Image size 1932x1916
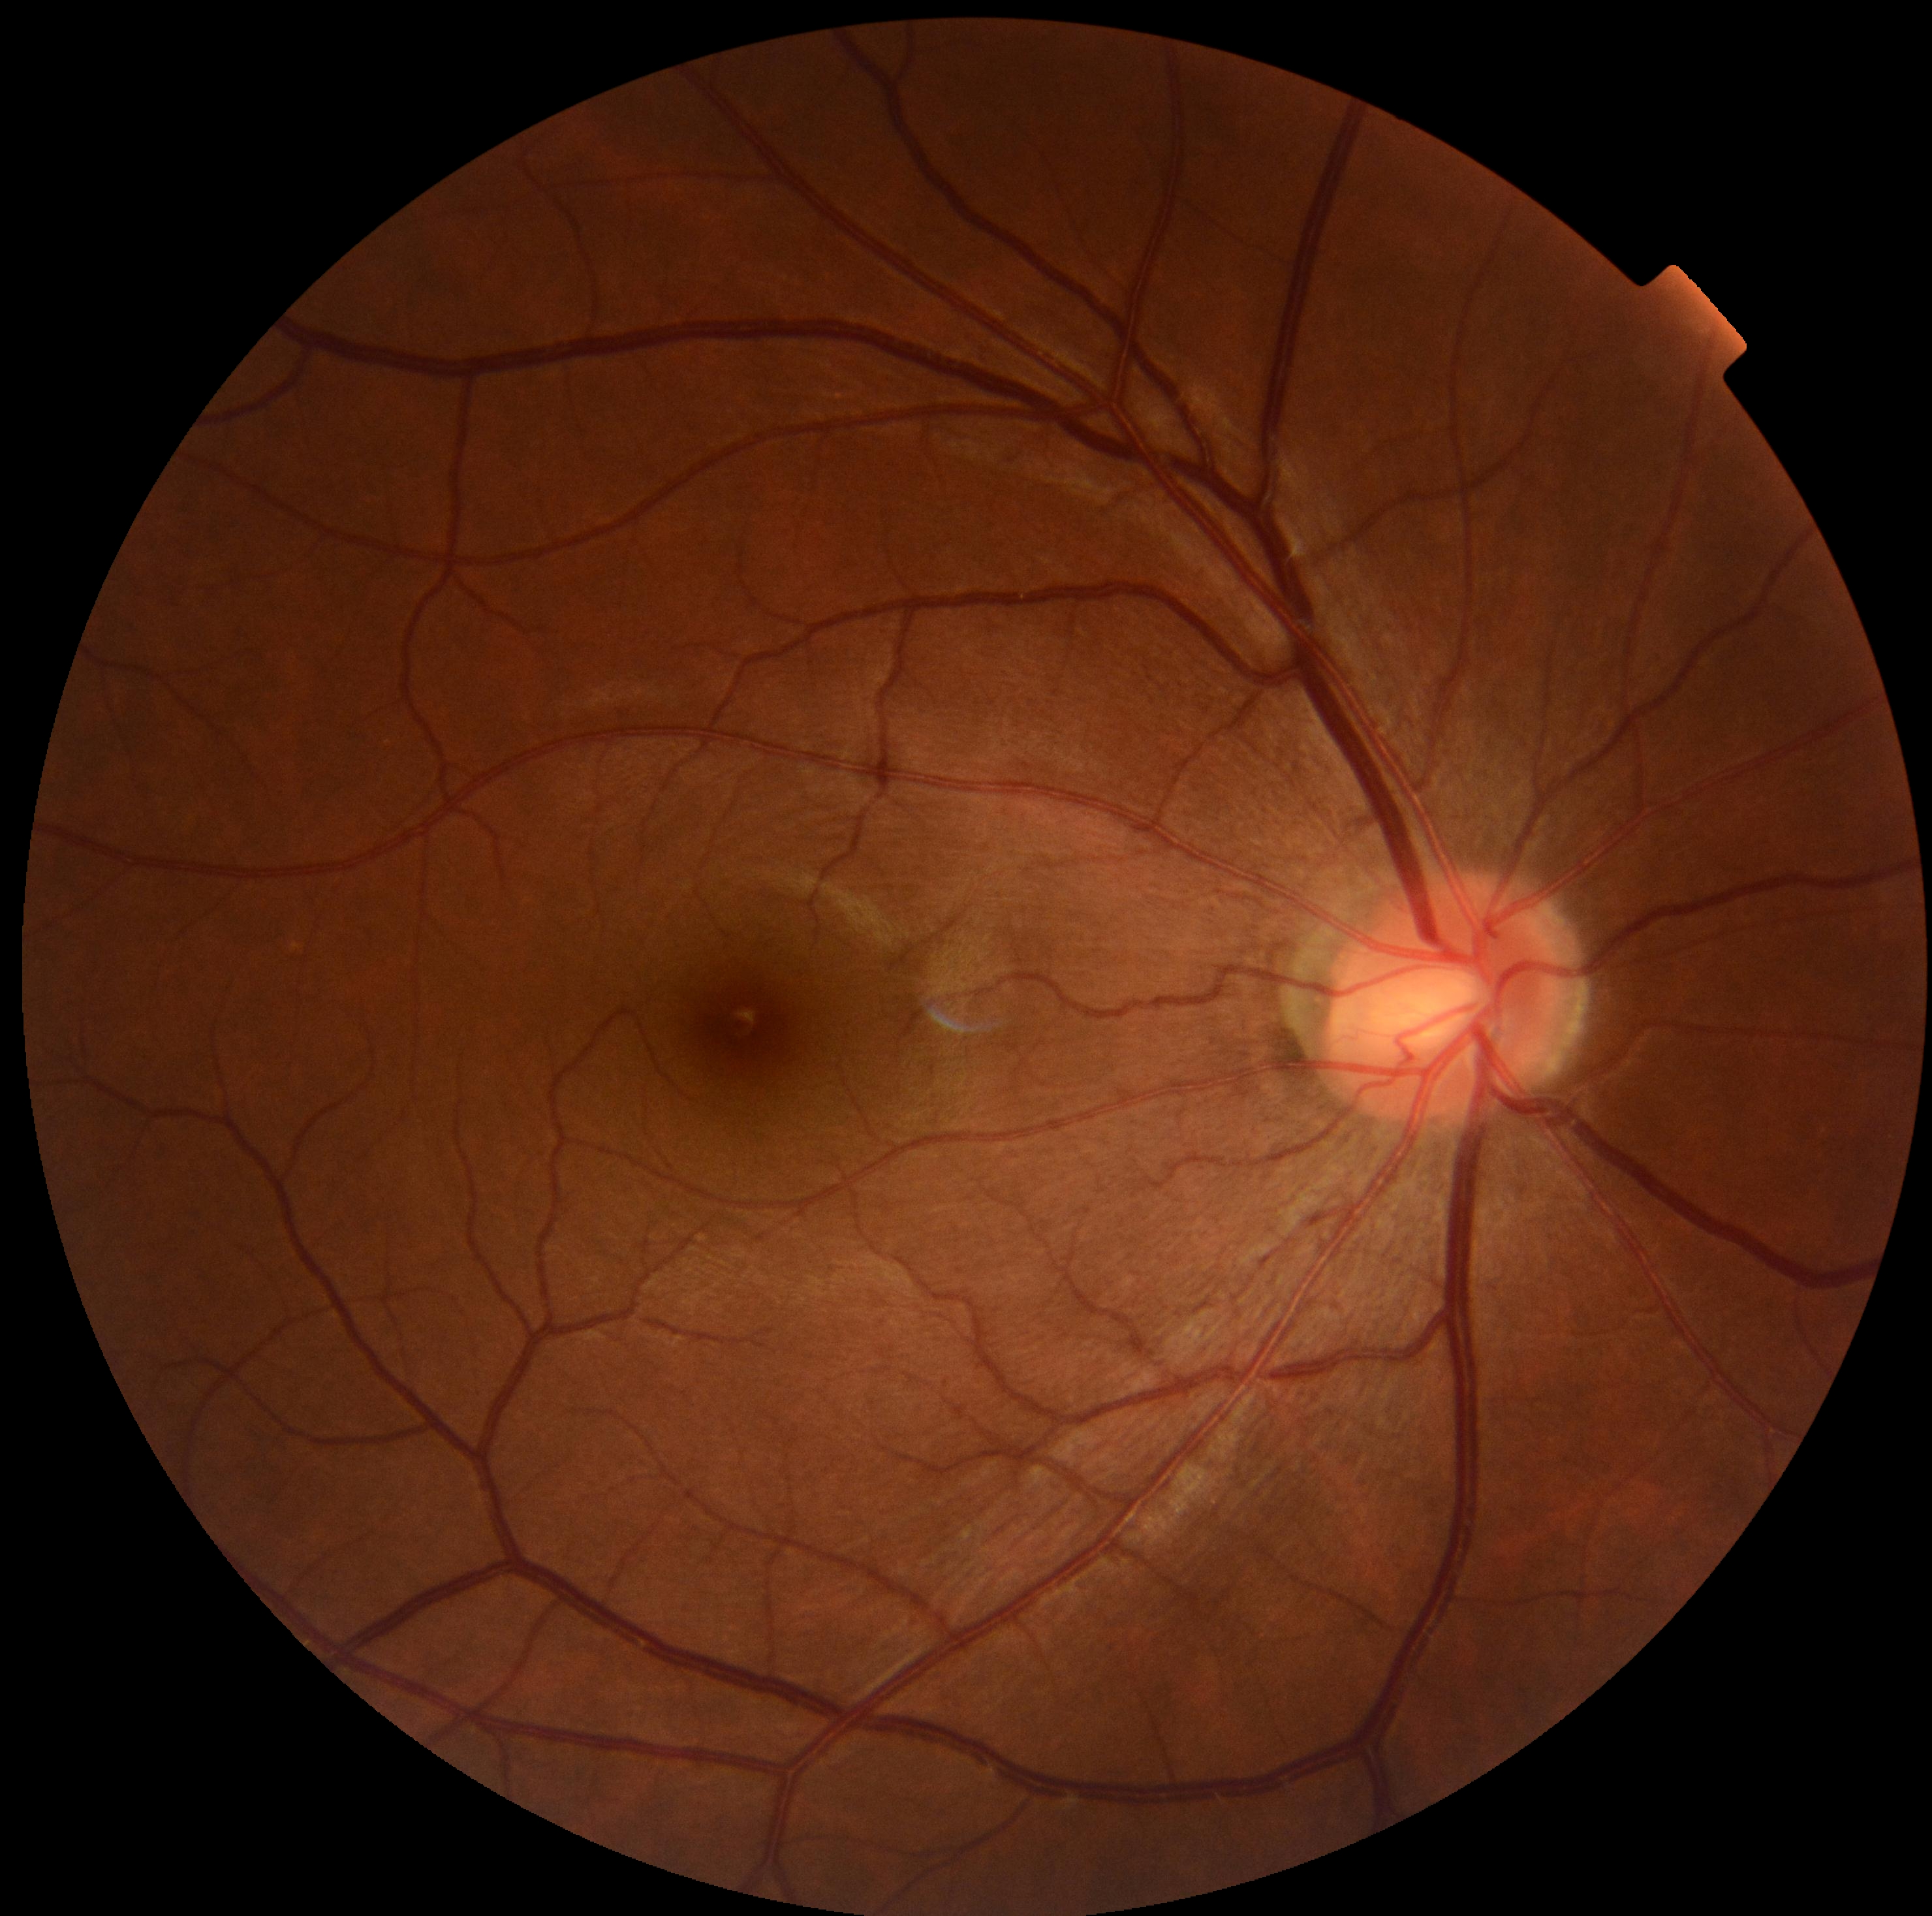 DR impression: negative for DR
diabetic retinopathy severity: no apparent retinopathy (grade 0)